Acquired on the Phoenix ICON · pediatric retinal photograph (wide-field): 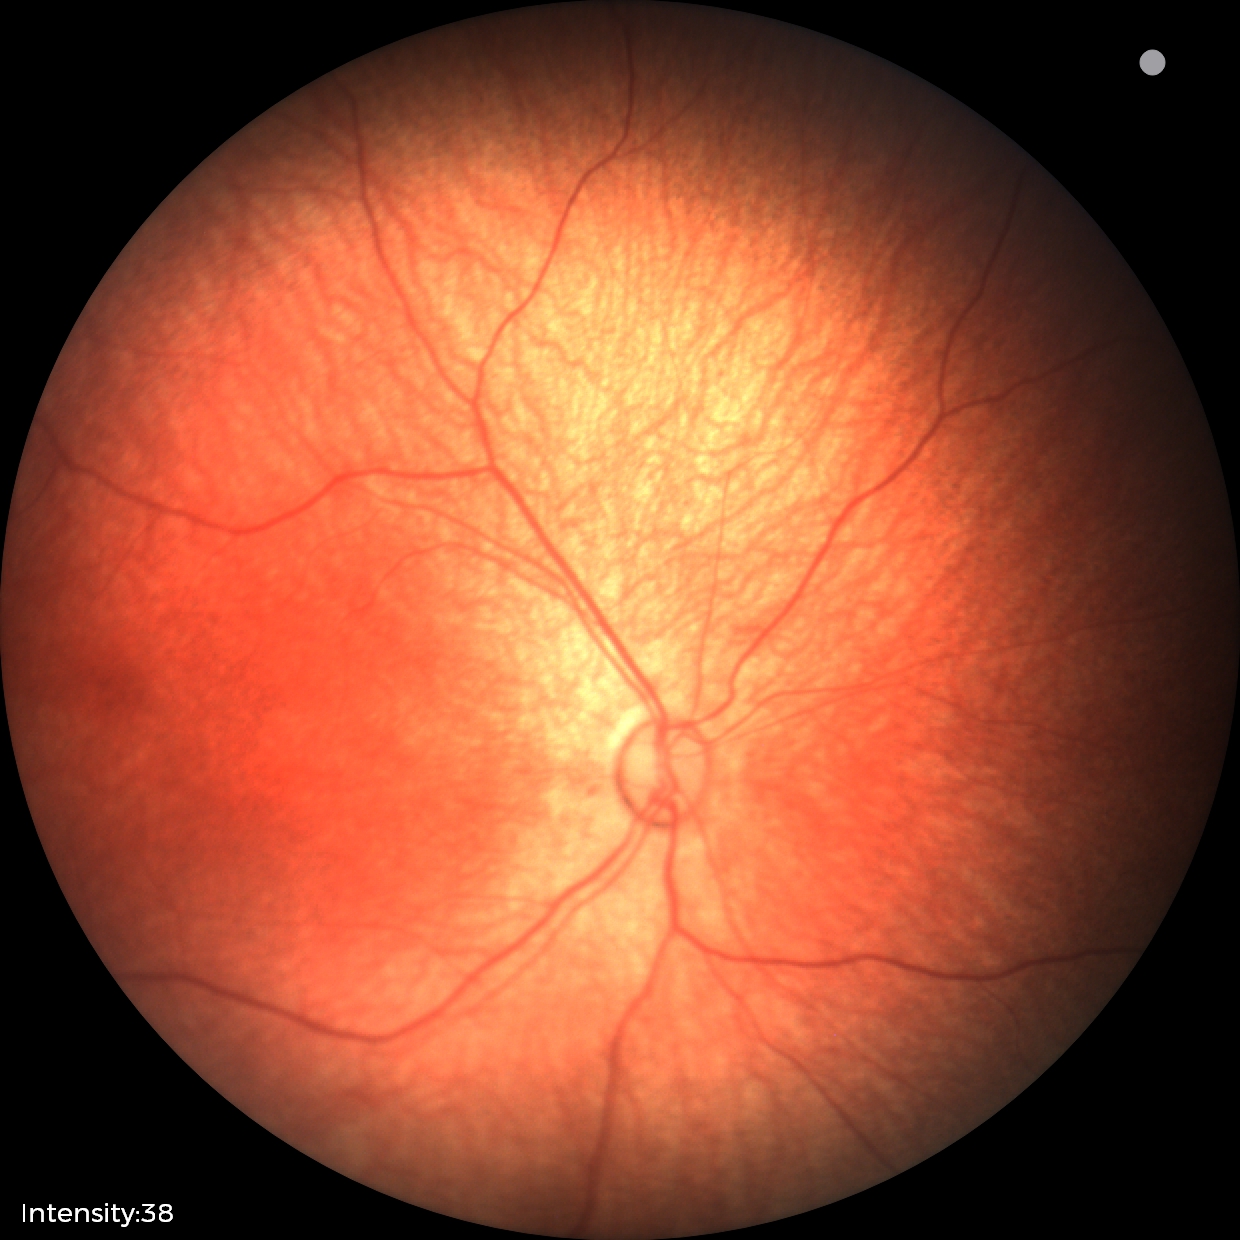

Diagnosis: no abnormalities